45° field of view. 2352x1568. CFP — 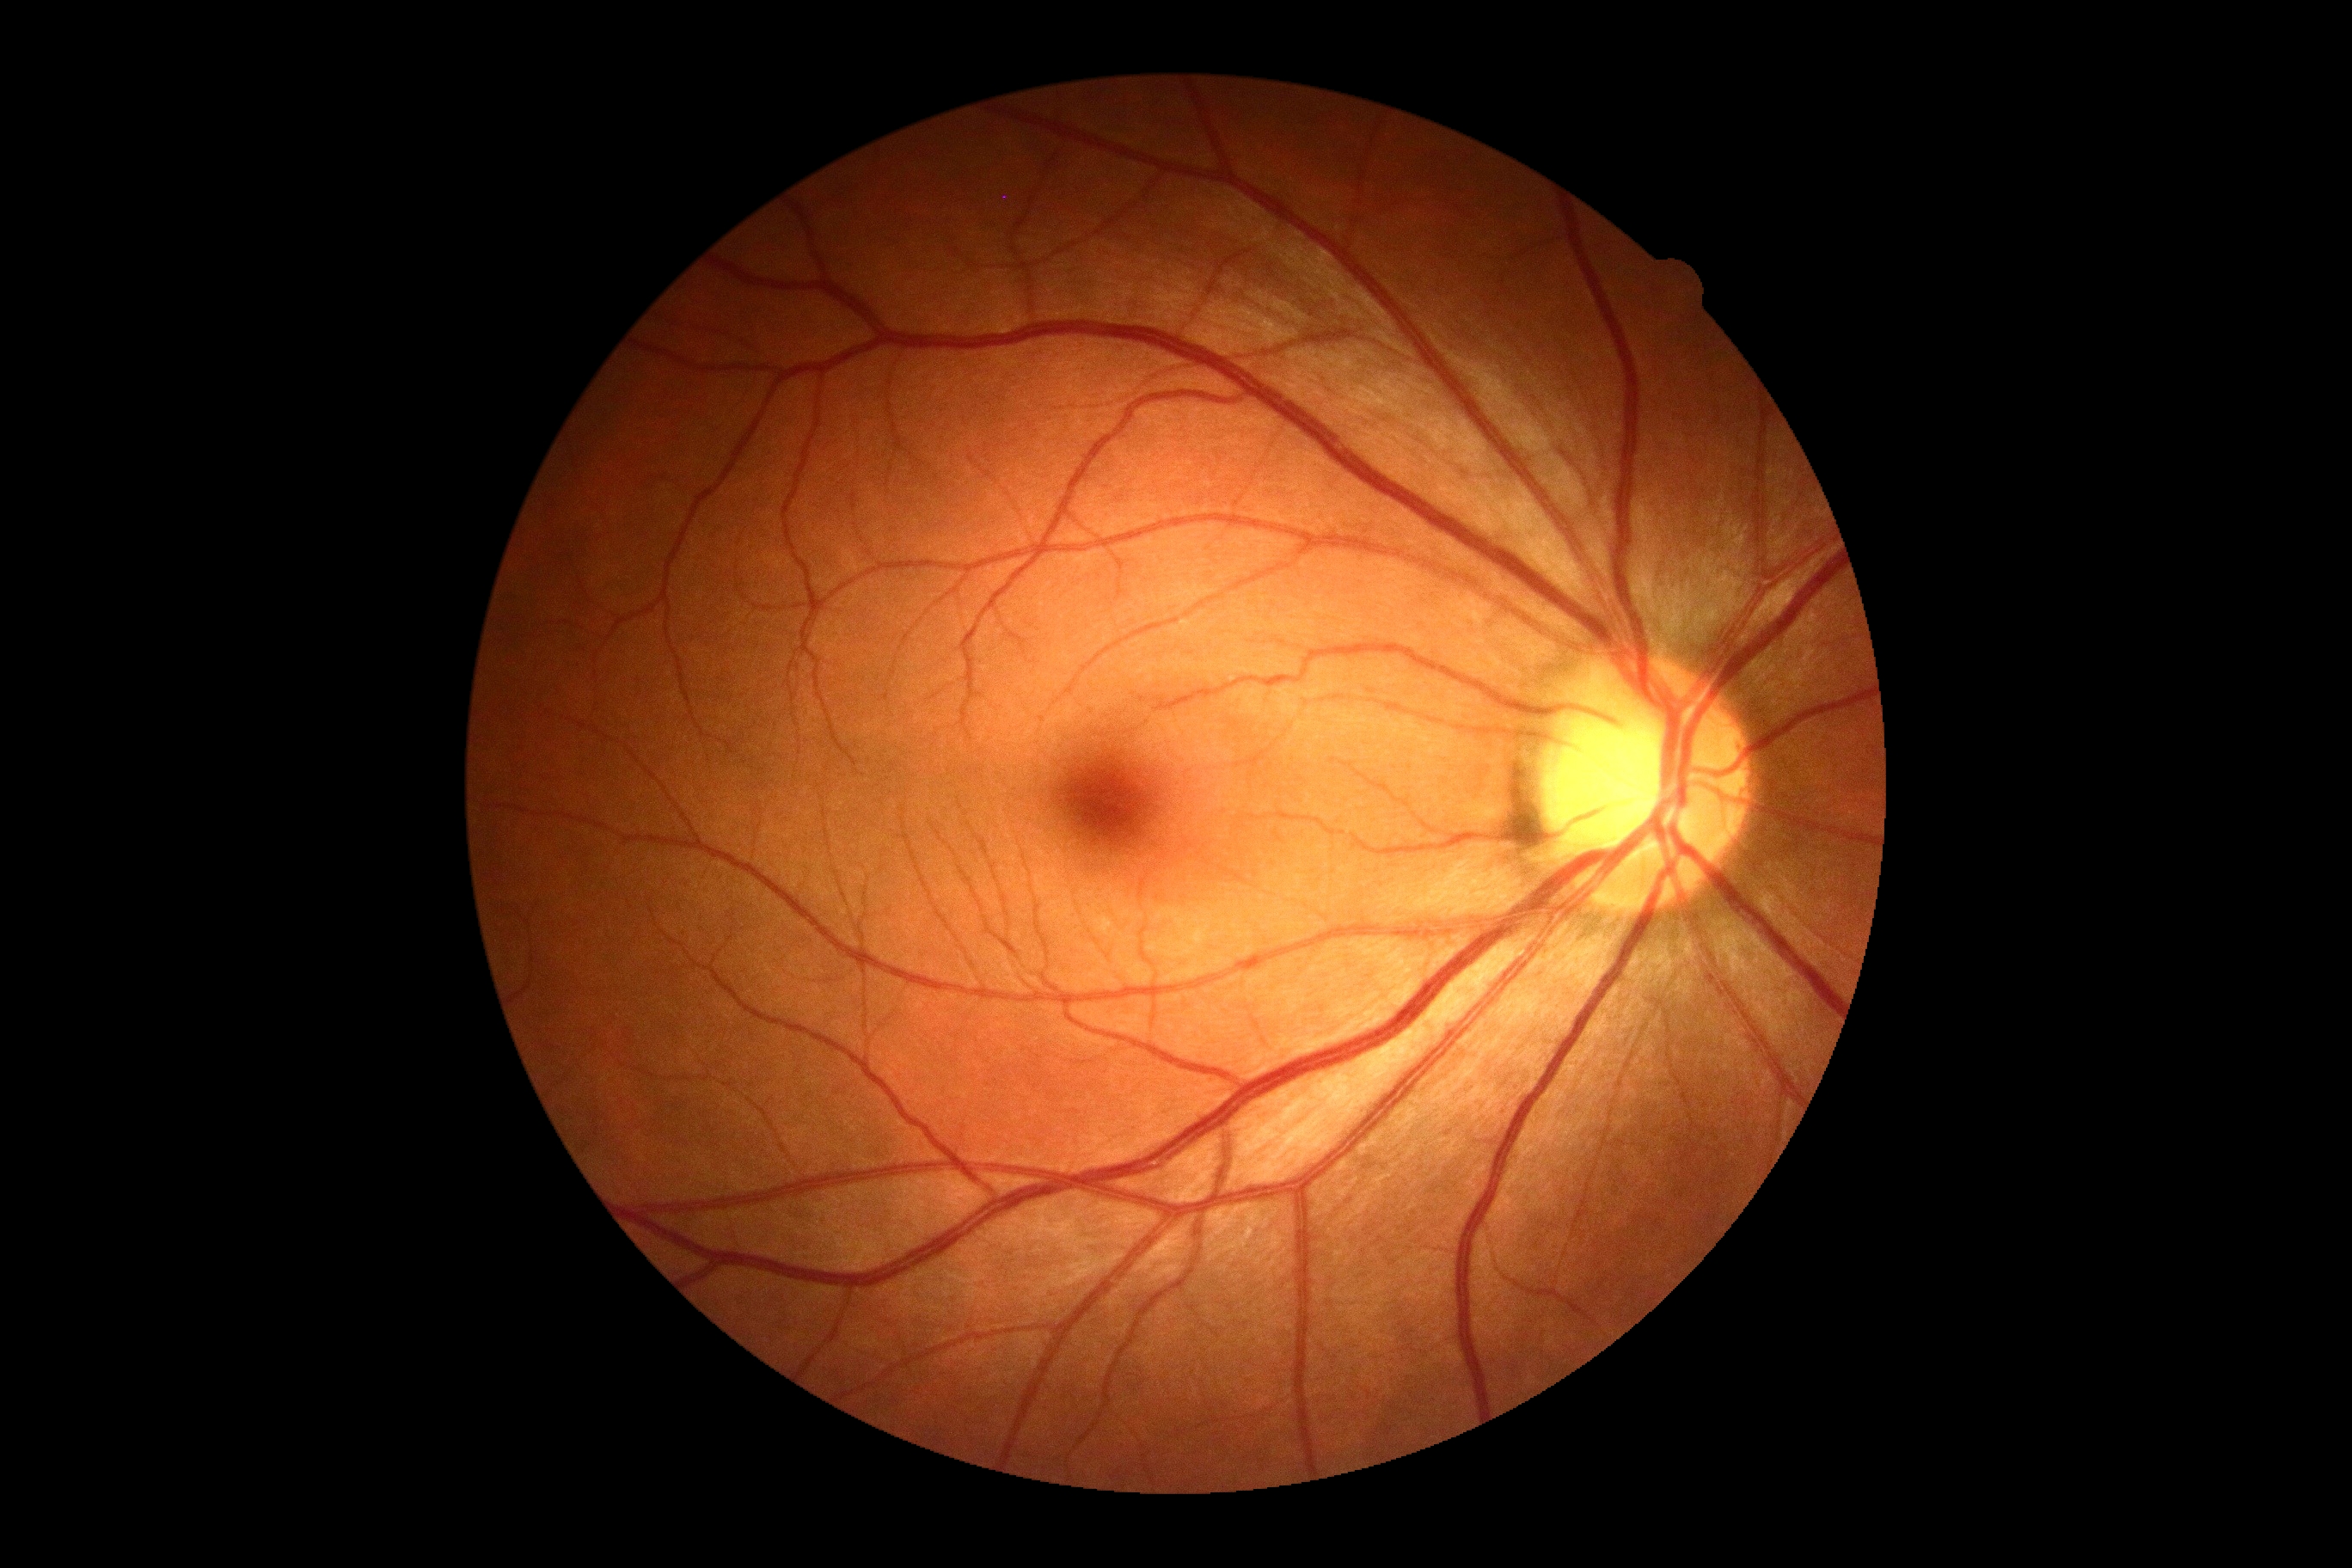 Diabetic retinopathy is 0.